45 degree fundus photograph; image size 848x848 — 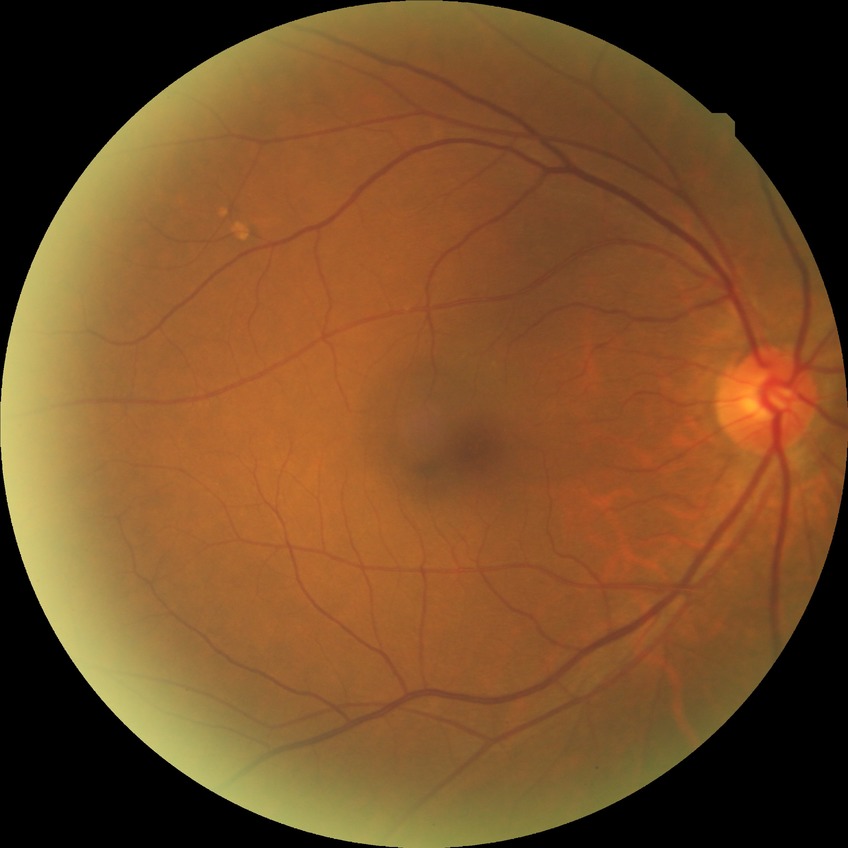
No signs of diabetic retinopathy. DR grade is NDR.